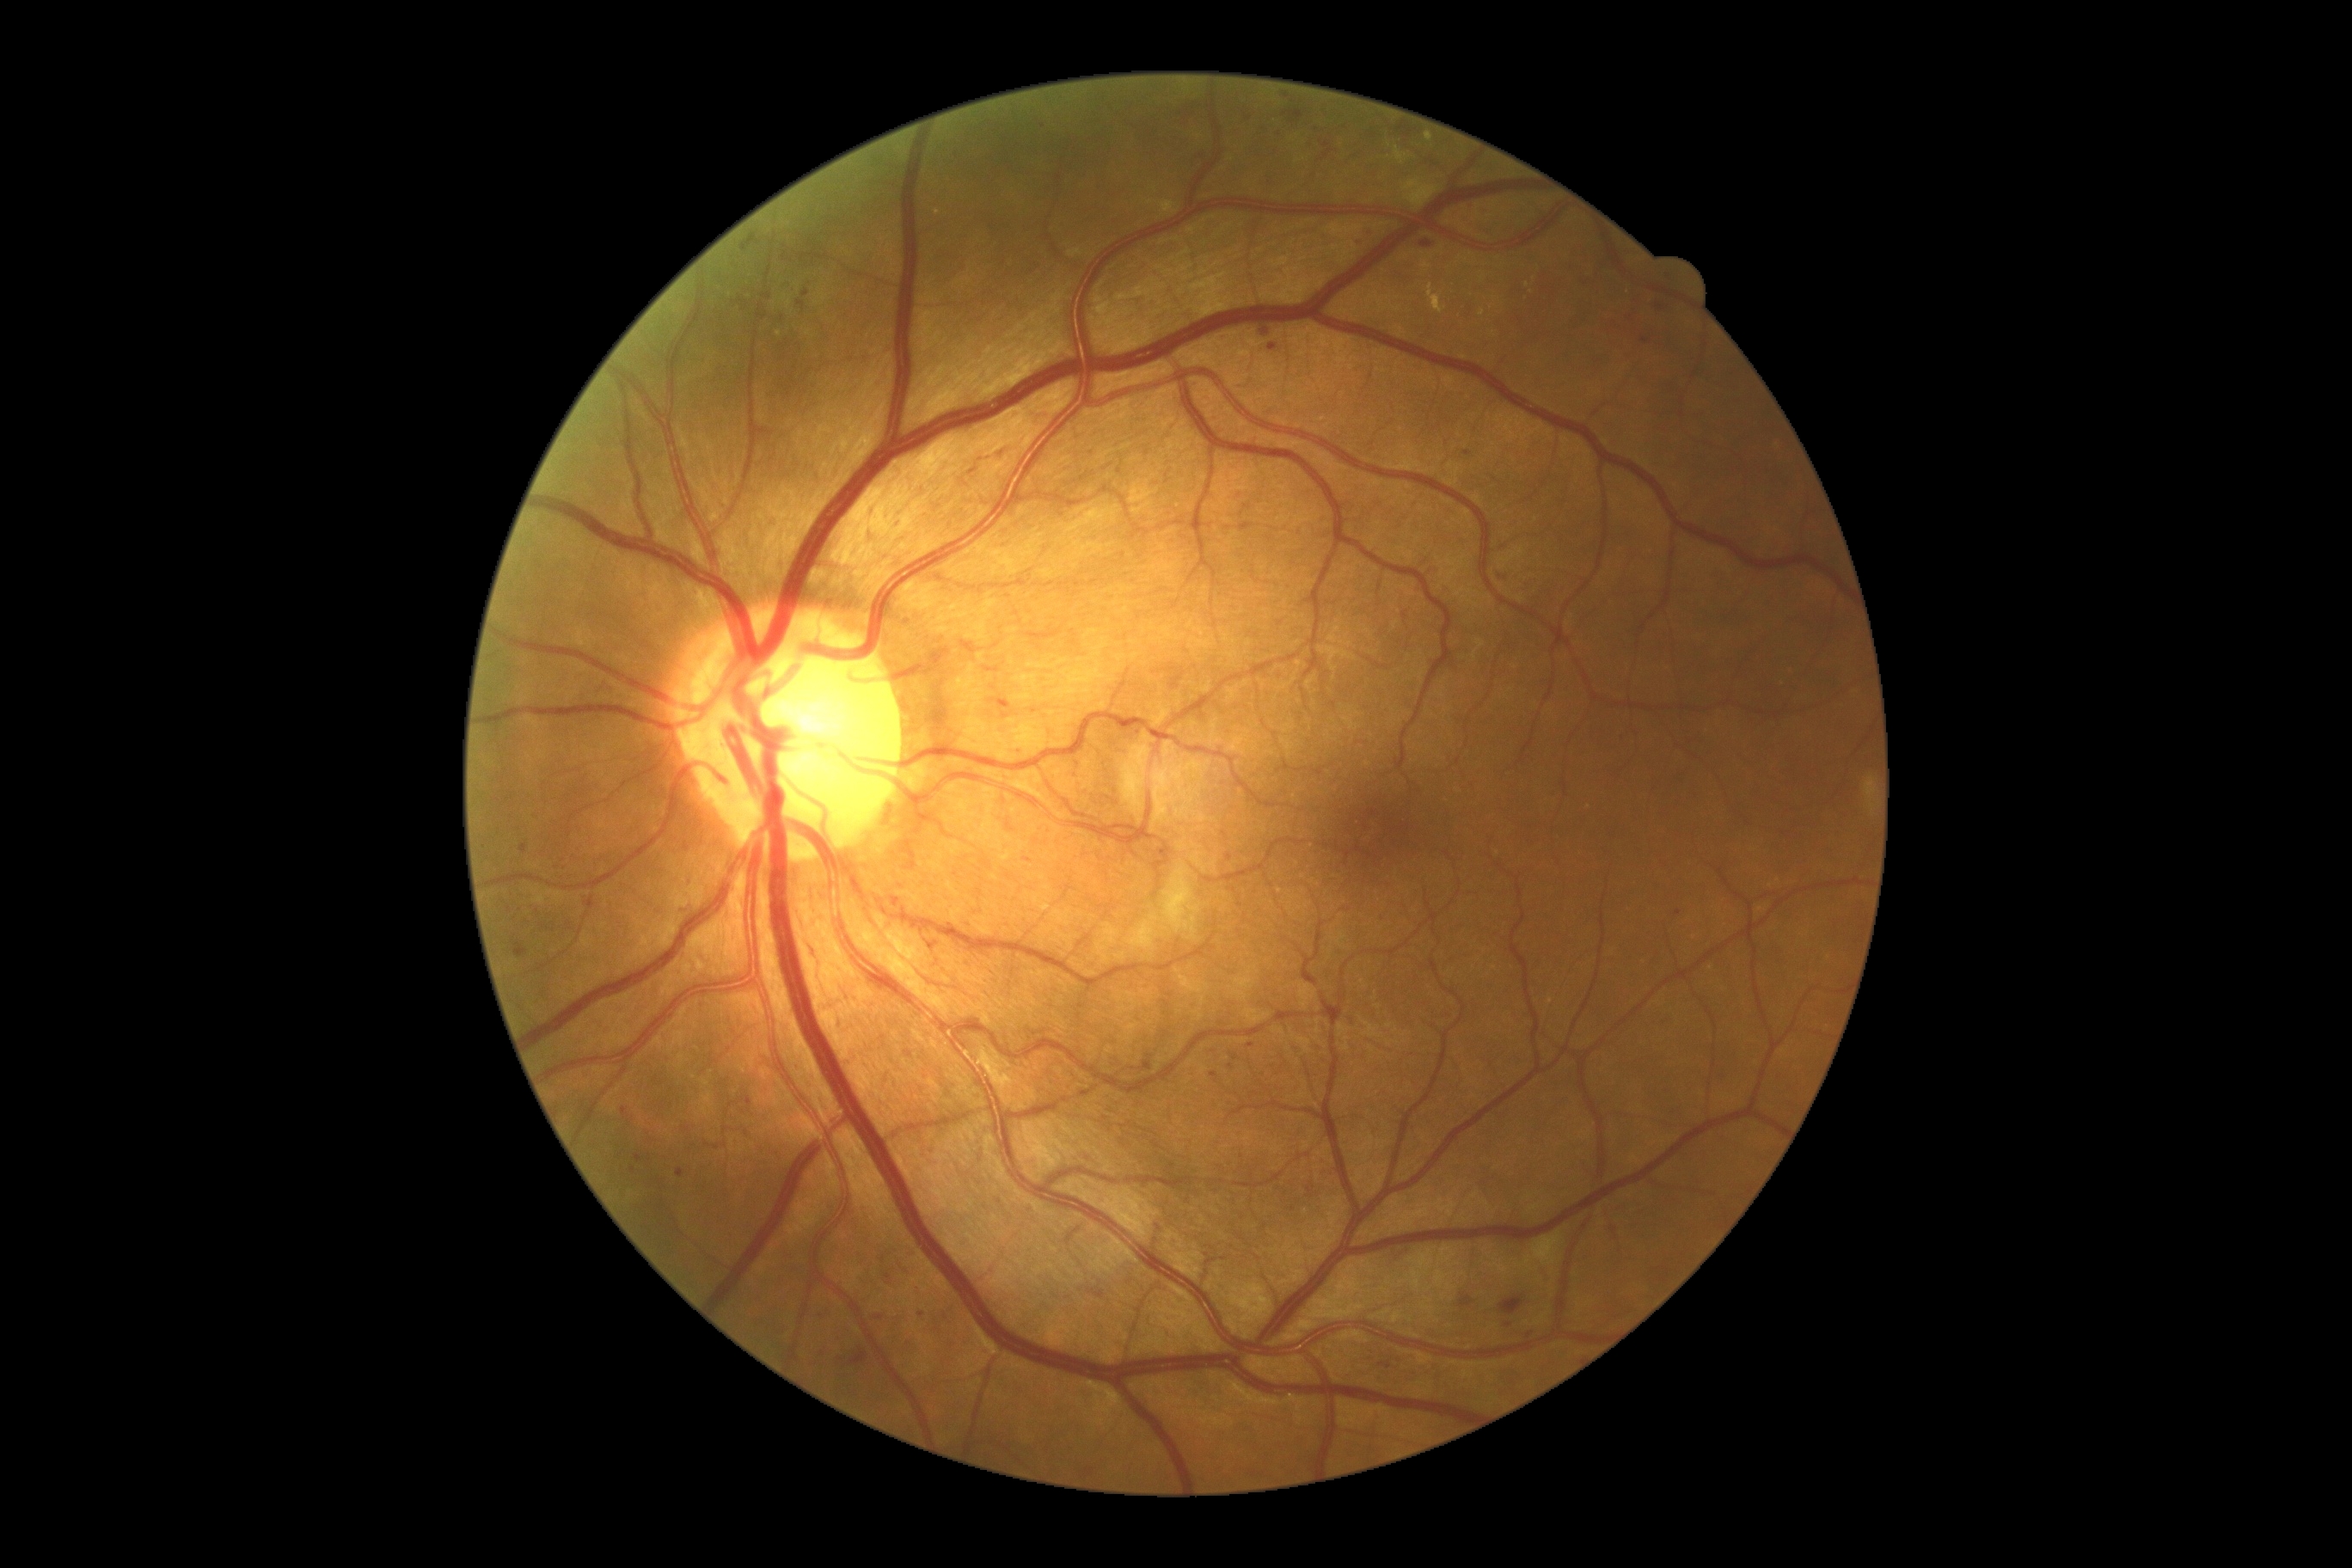 DR severity is grade 2 (moderate NPDR). MAs include lesions at bbox(1500, 1297, 1524, 1316), bbox(635, 1155, 644, 1163), bbox(1581, 279, 1588, 290), bbox(1320, 142, 1333, 162), bbox(993, 699, 1012, 709), bbox(1244, 114, 1253, 121). Additional small MAs near (1373,135), (1240,905), (1077,776), (840,1361), (1214,1077), (1282,135), (633,1170), (1273,347), (1042,126), (1672,279). No HEs identified. No SEs identified. EXs include lesions at bbox(1395, 149, 1409, 164), bbox(1424, 133, 1433, 142), bbox(1428, 285, 1447, 314), bbox(1865, 775, 1877, 818), bbox(1160, 200, 1177, 214). Additional small EXs near (778,335), (1483,279), (1482,313), (937,212), (1390,145), (1527,286).